1240x1240. Pediatric wide-field fundus photograph — 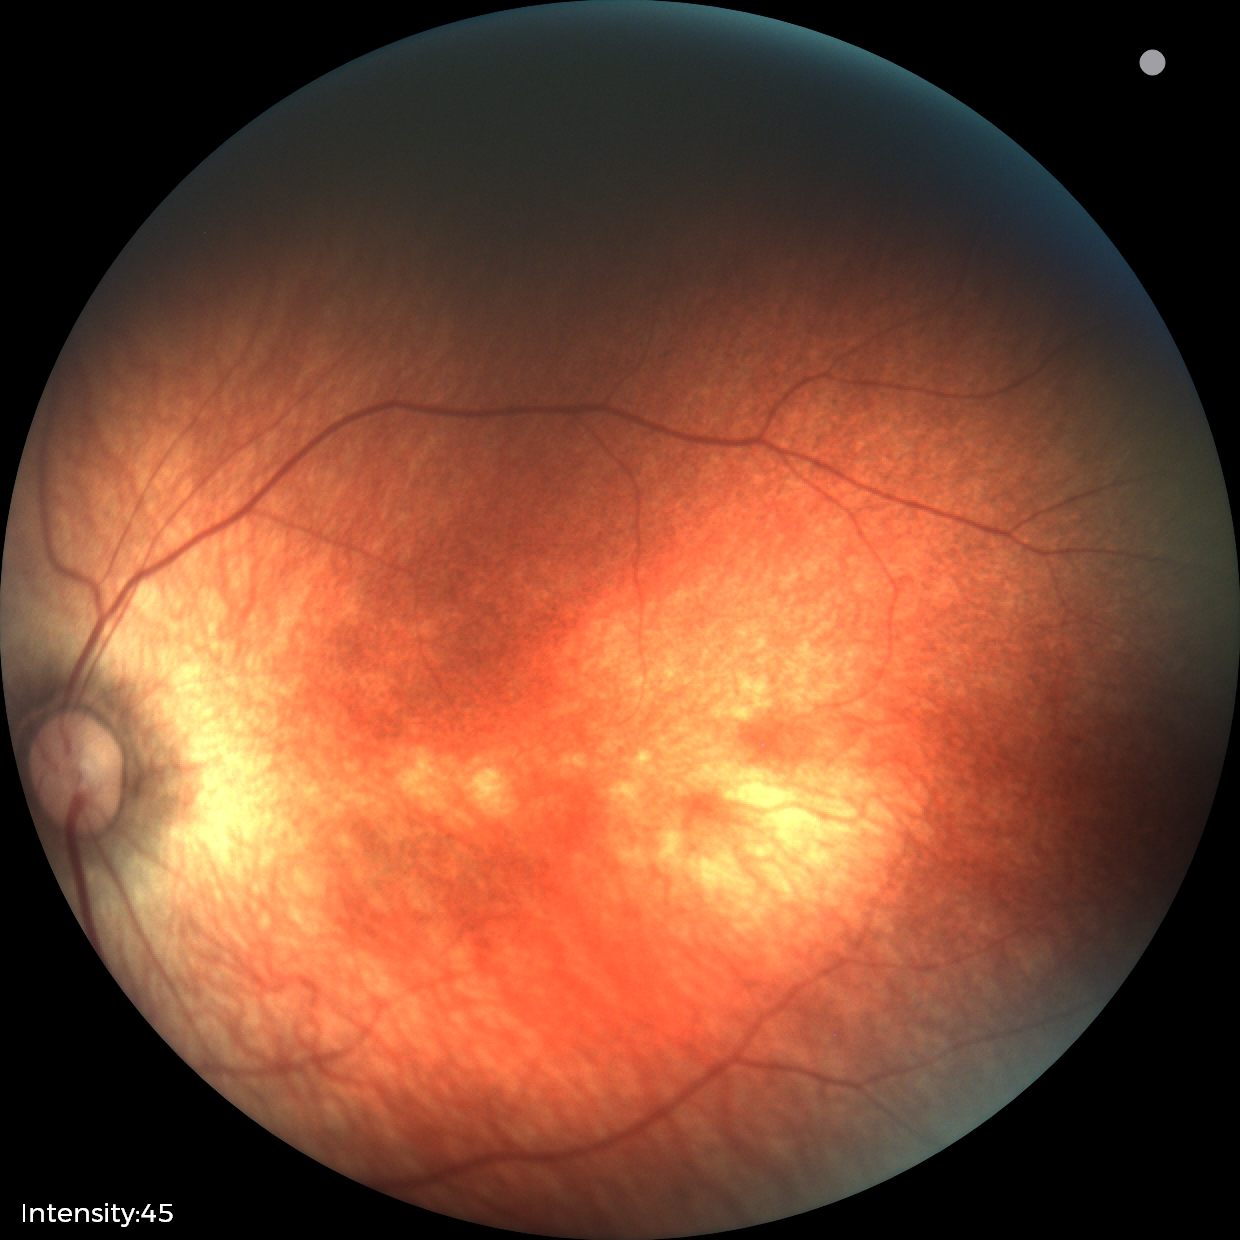
Screening examination with no abnormal retinal findings.